2048 x 1536 pixels · color fundus photograph:
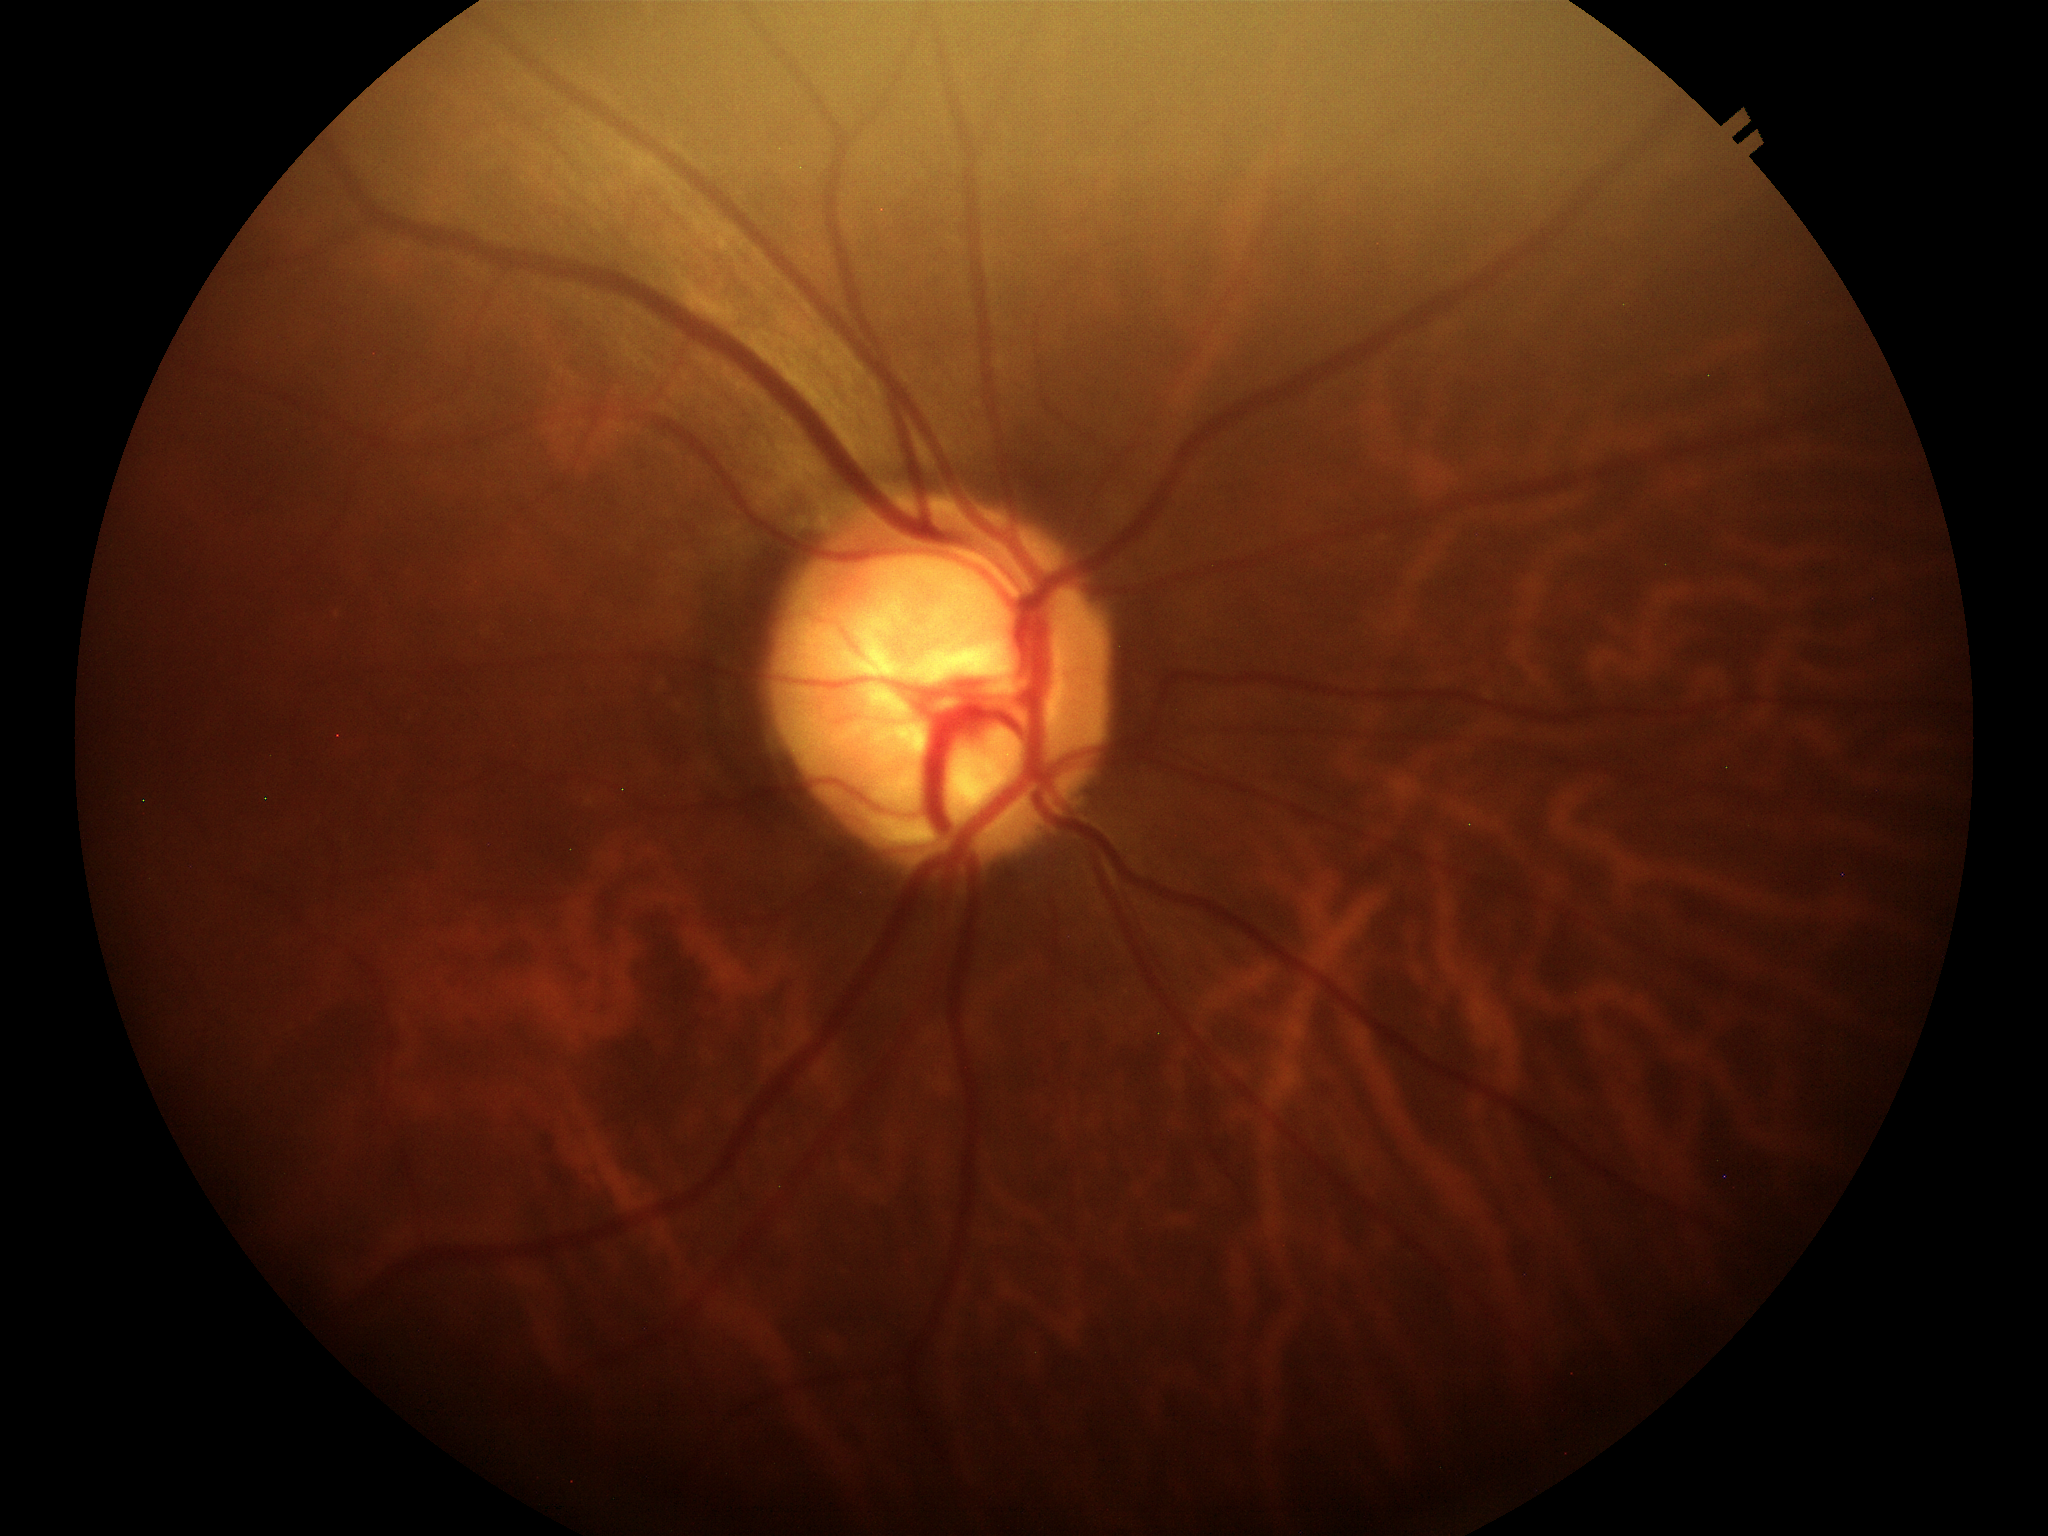
Glaucoma suspect. VCDR is 0.80. ACDR is 0.55.